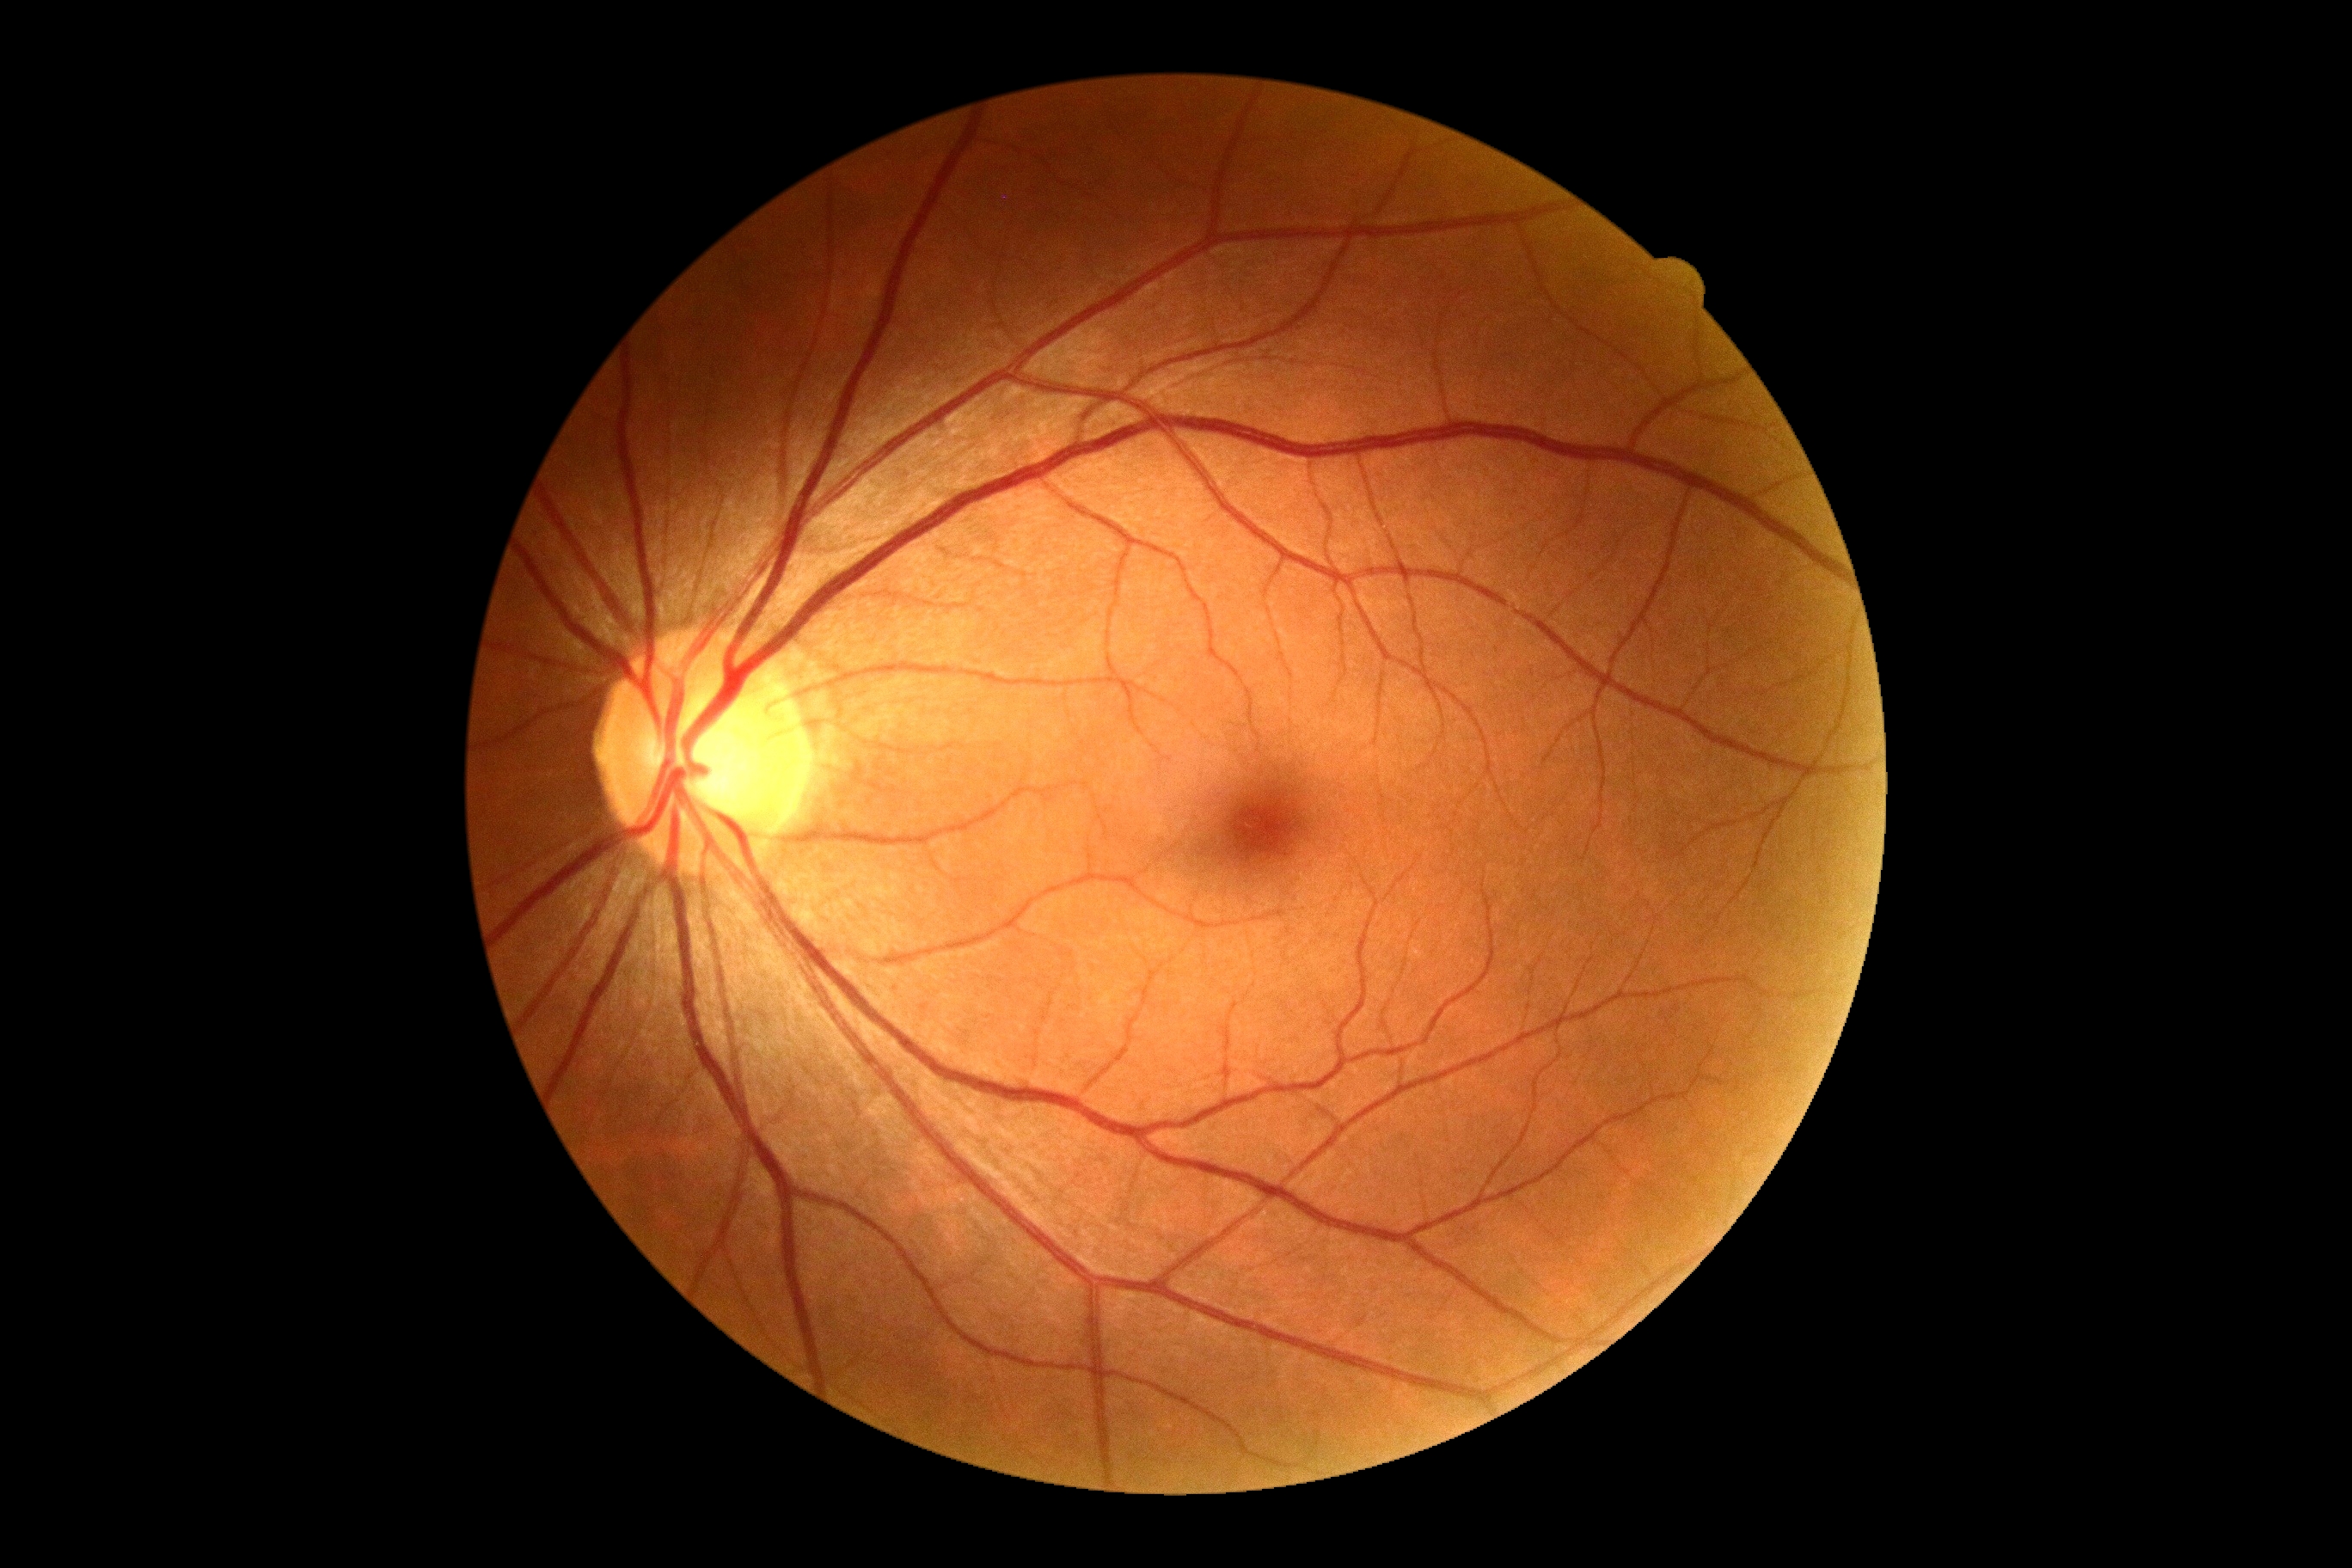
{"dr_grade": "no apparent diabetic retinopathy (0)"}